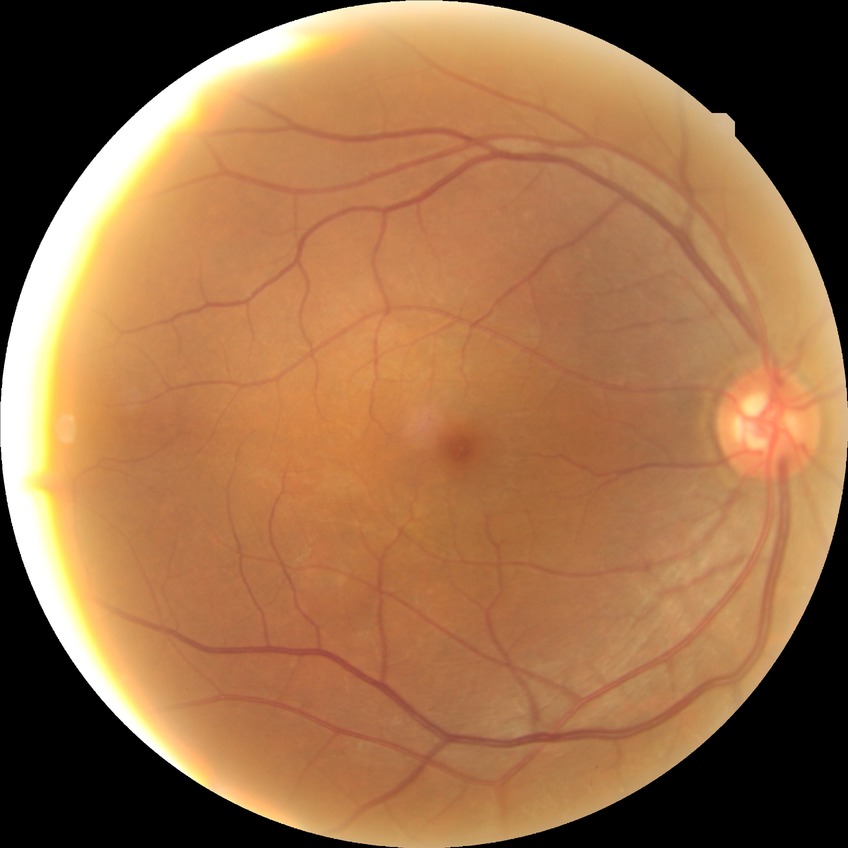
{"davis_grade": "no diabetic retinopathy"}